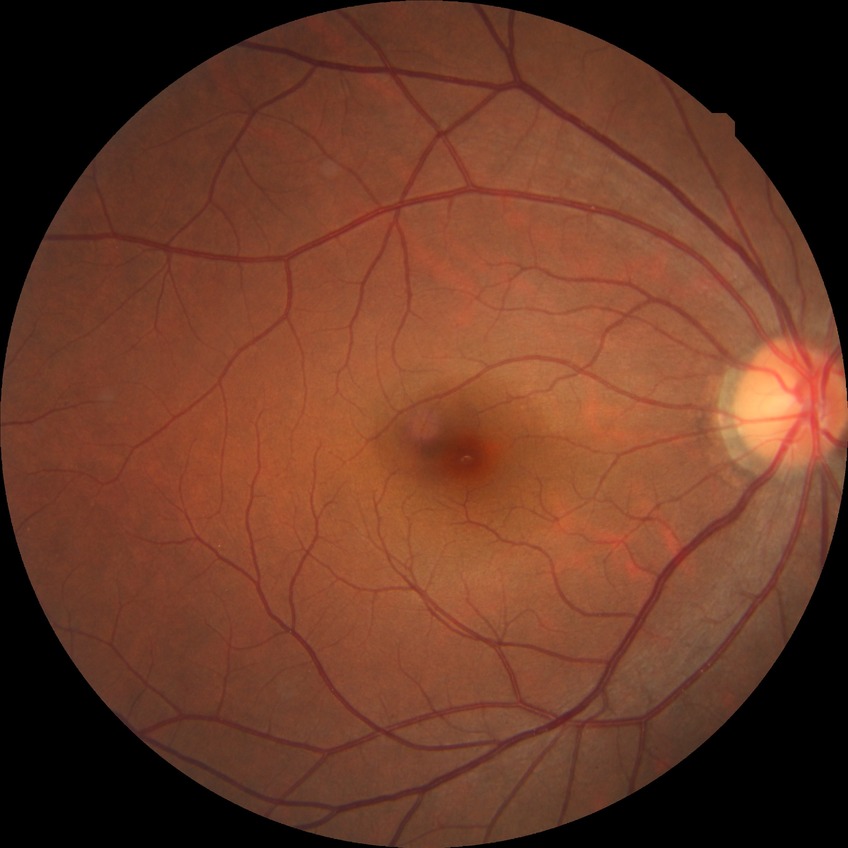 Diabetic retinopathy (DR): NDR (no diabetic retinopathy).